Without pupil dilation; 848 by 848 pixels; color fundus image: 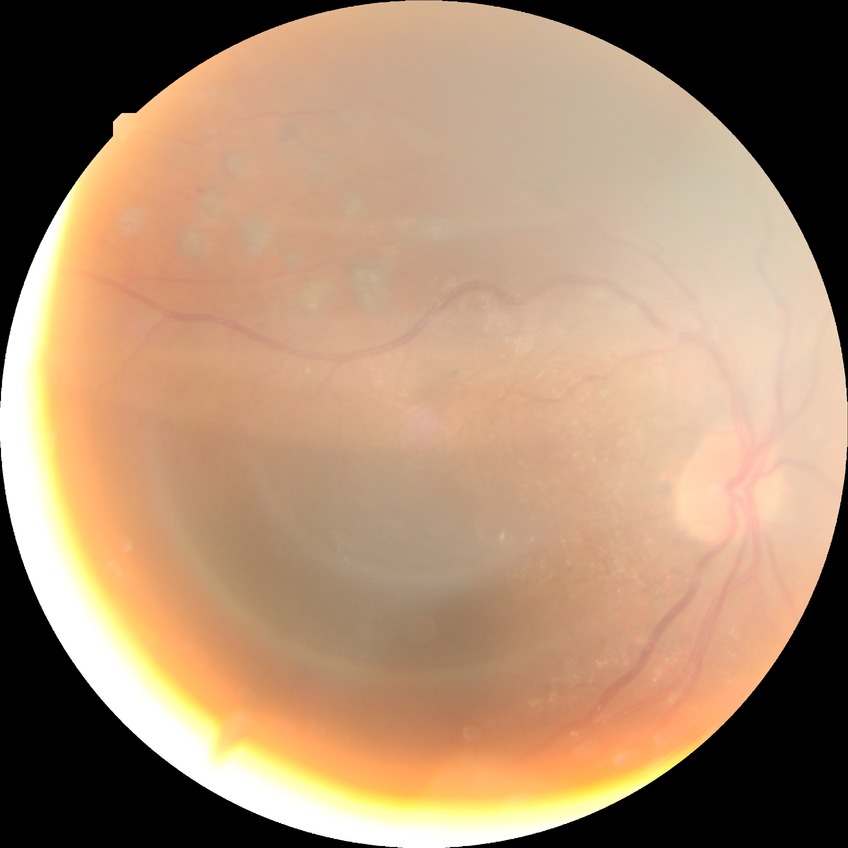
Diabetic retinopathy stage is proliferative diabetic retinopathy.